Phoenix ICON wide-field infant fundus image. 1240x1240px. Captured with the Phoenix ICON (100° field of view) — 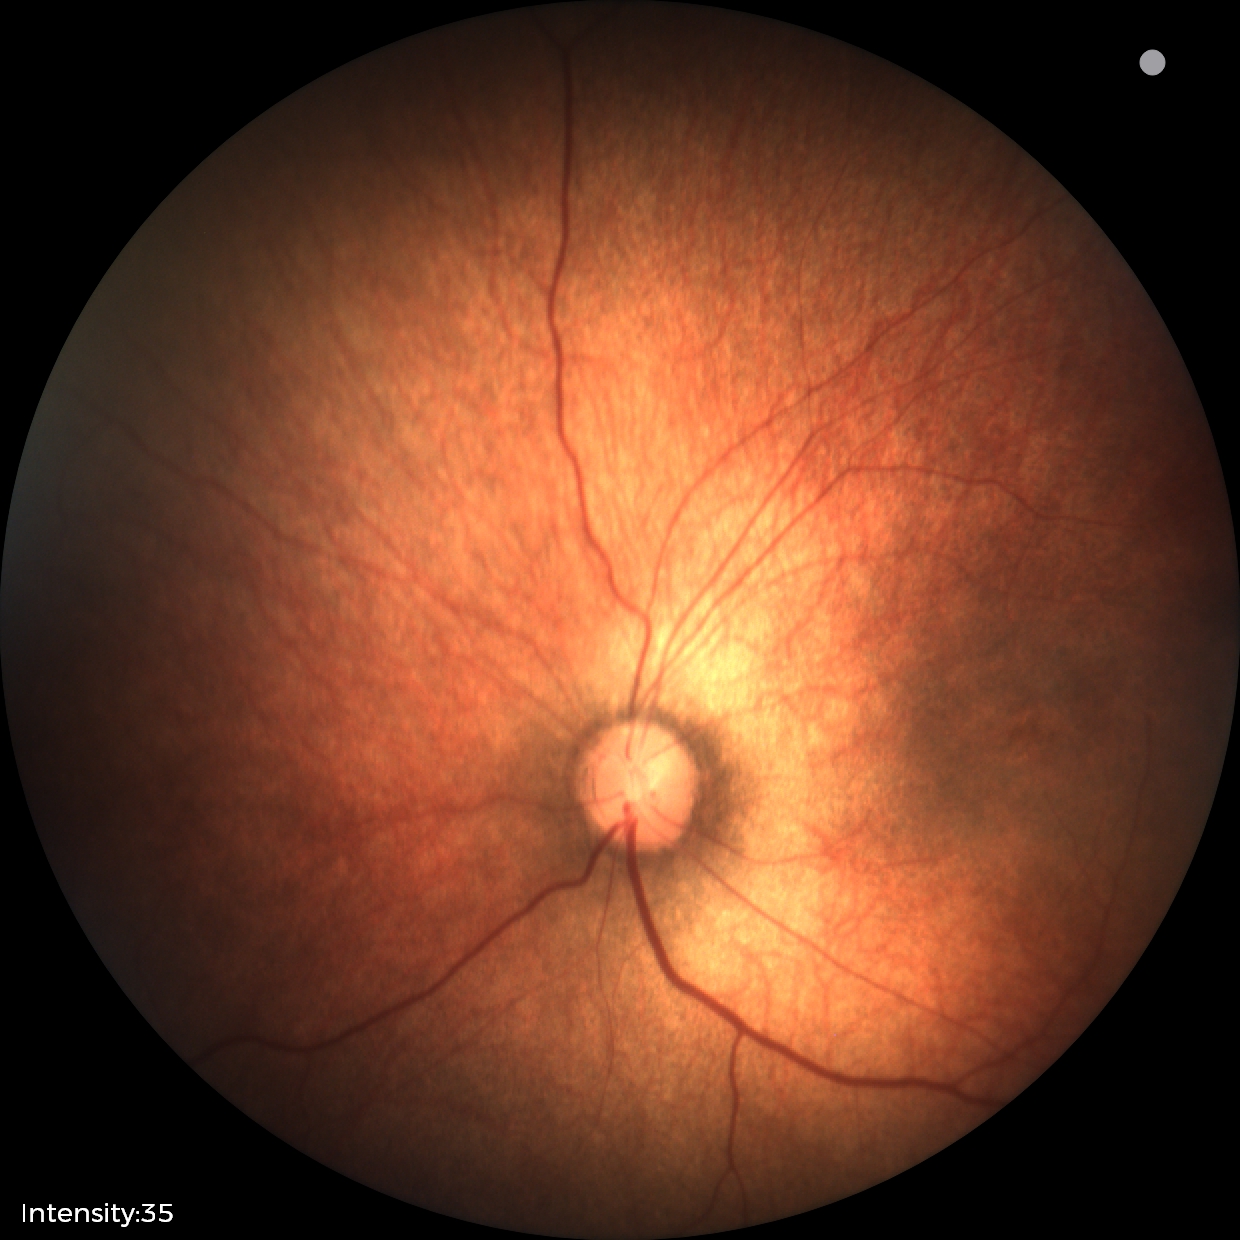

Examination with physiological retinal findings.